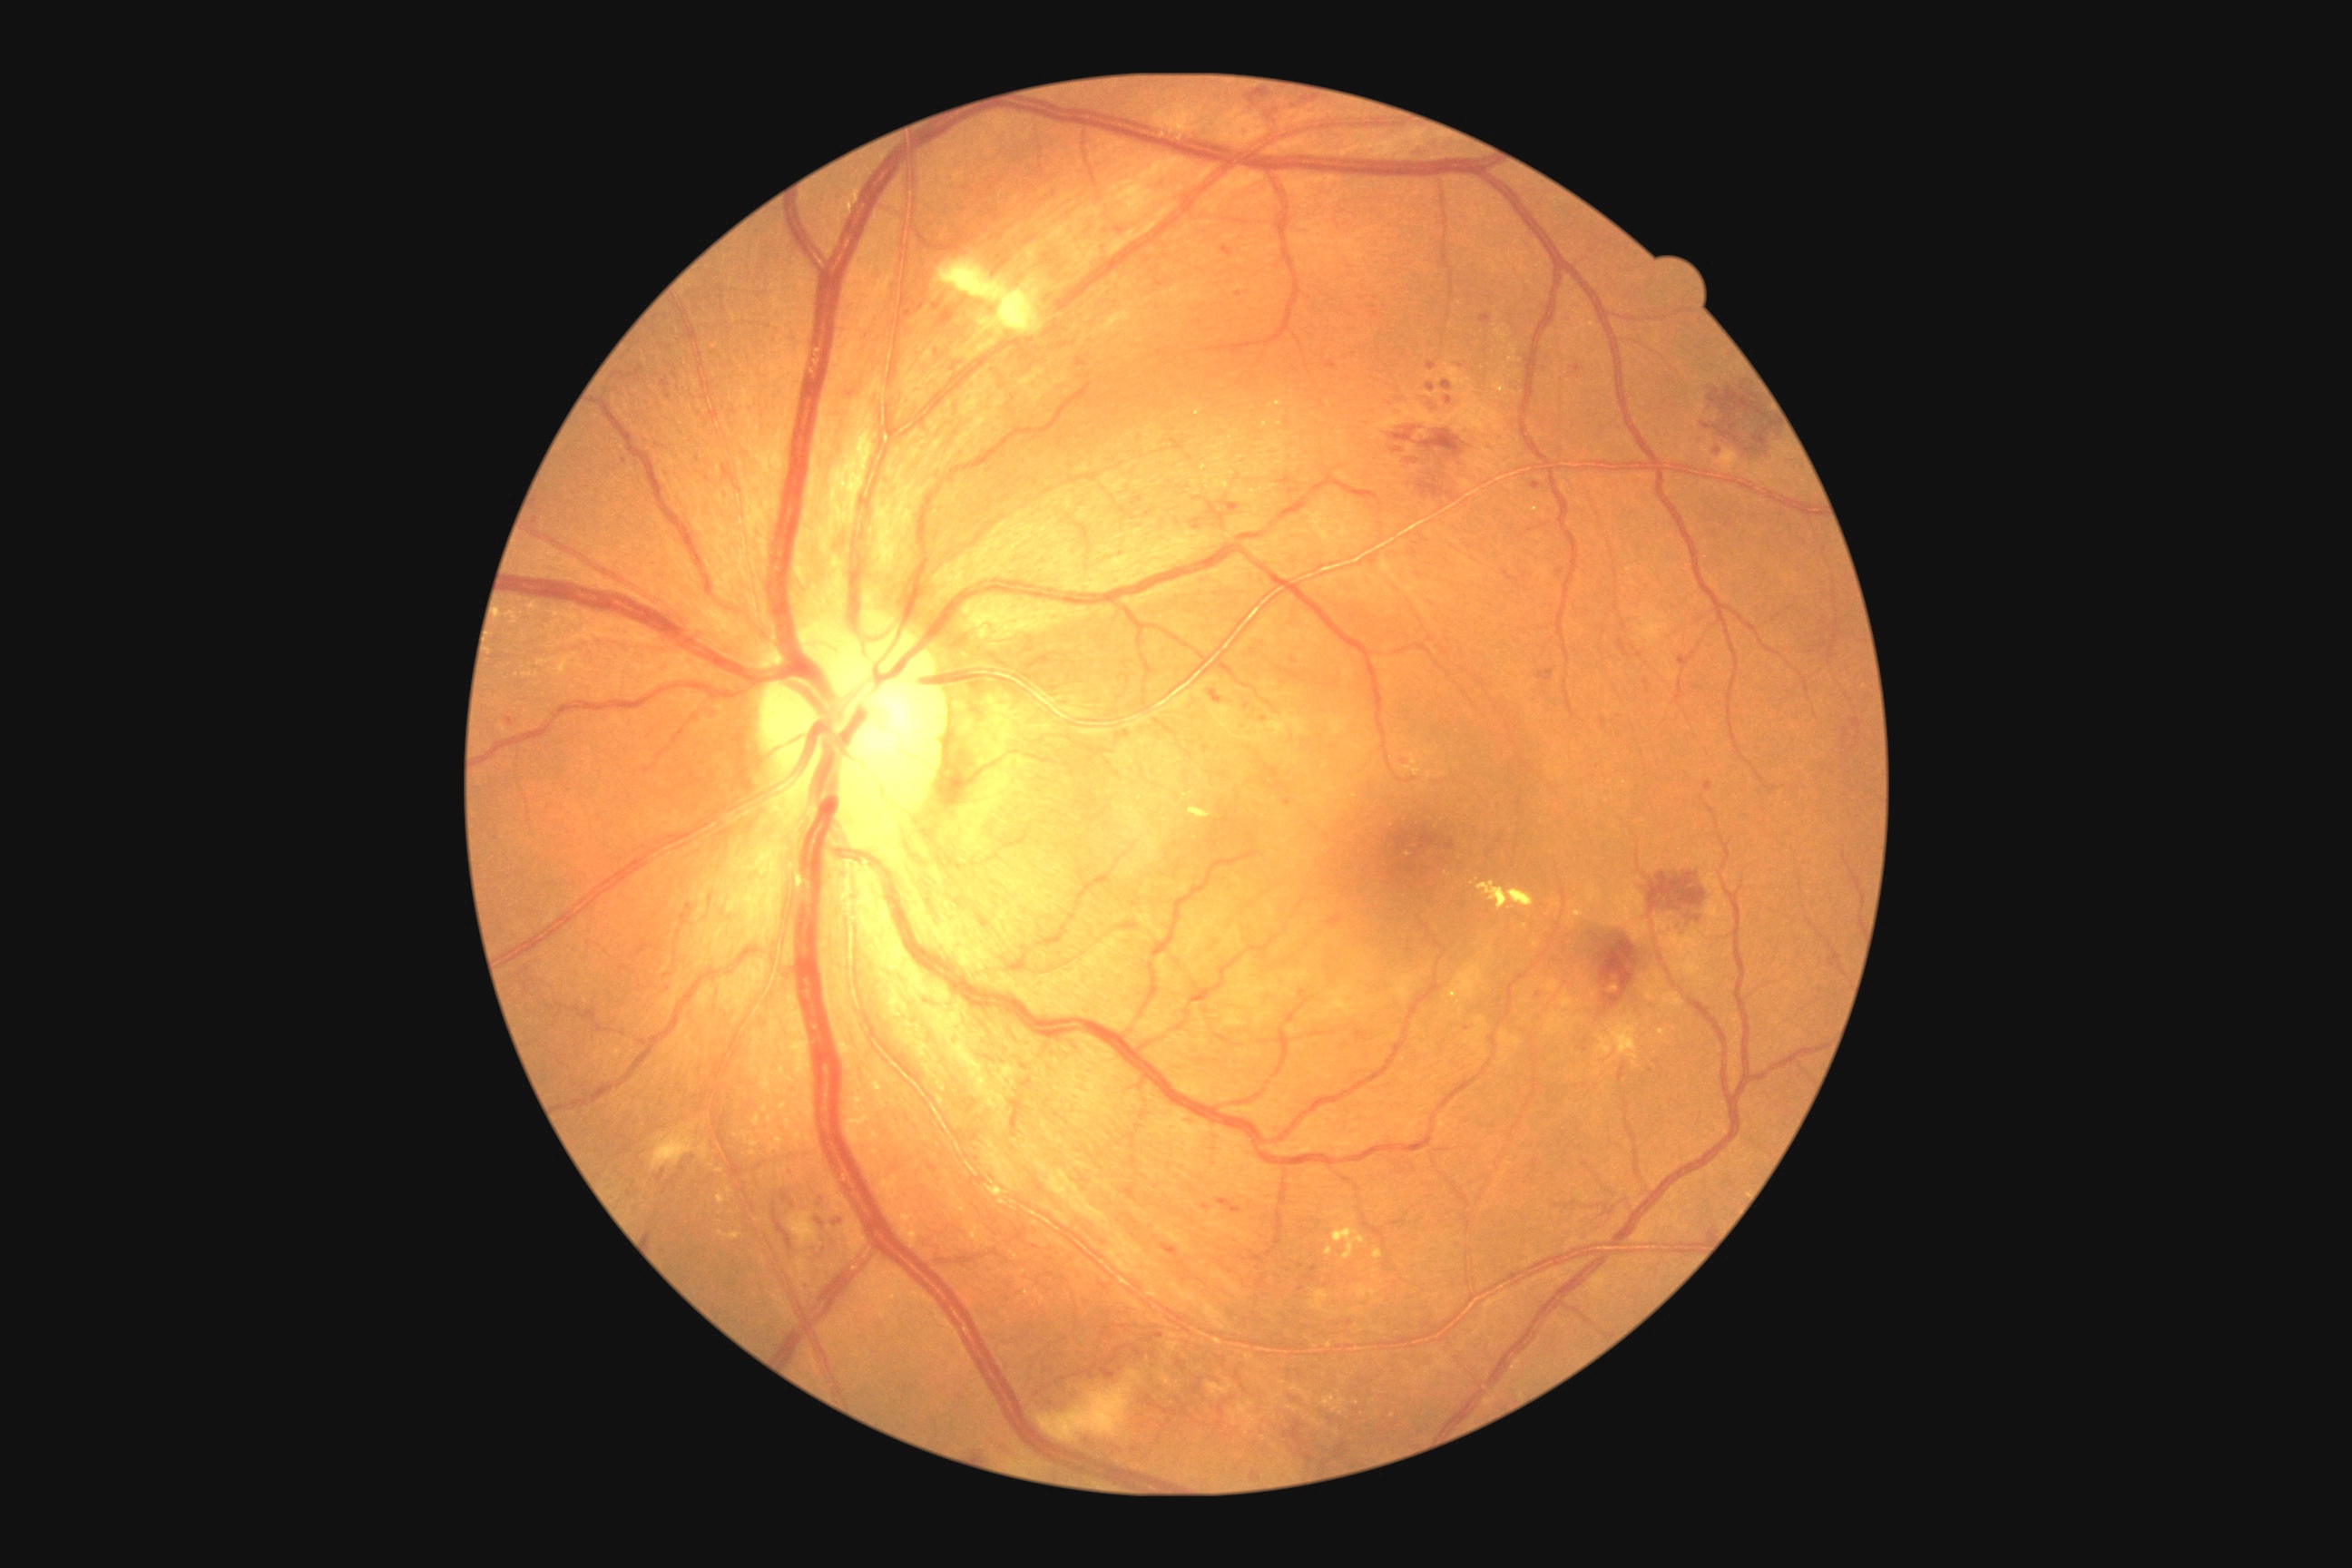
dr_grade: moderate non-proliferative diabetic retinopathy (grade 2)